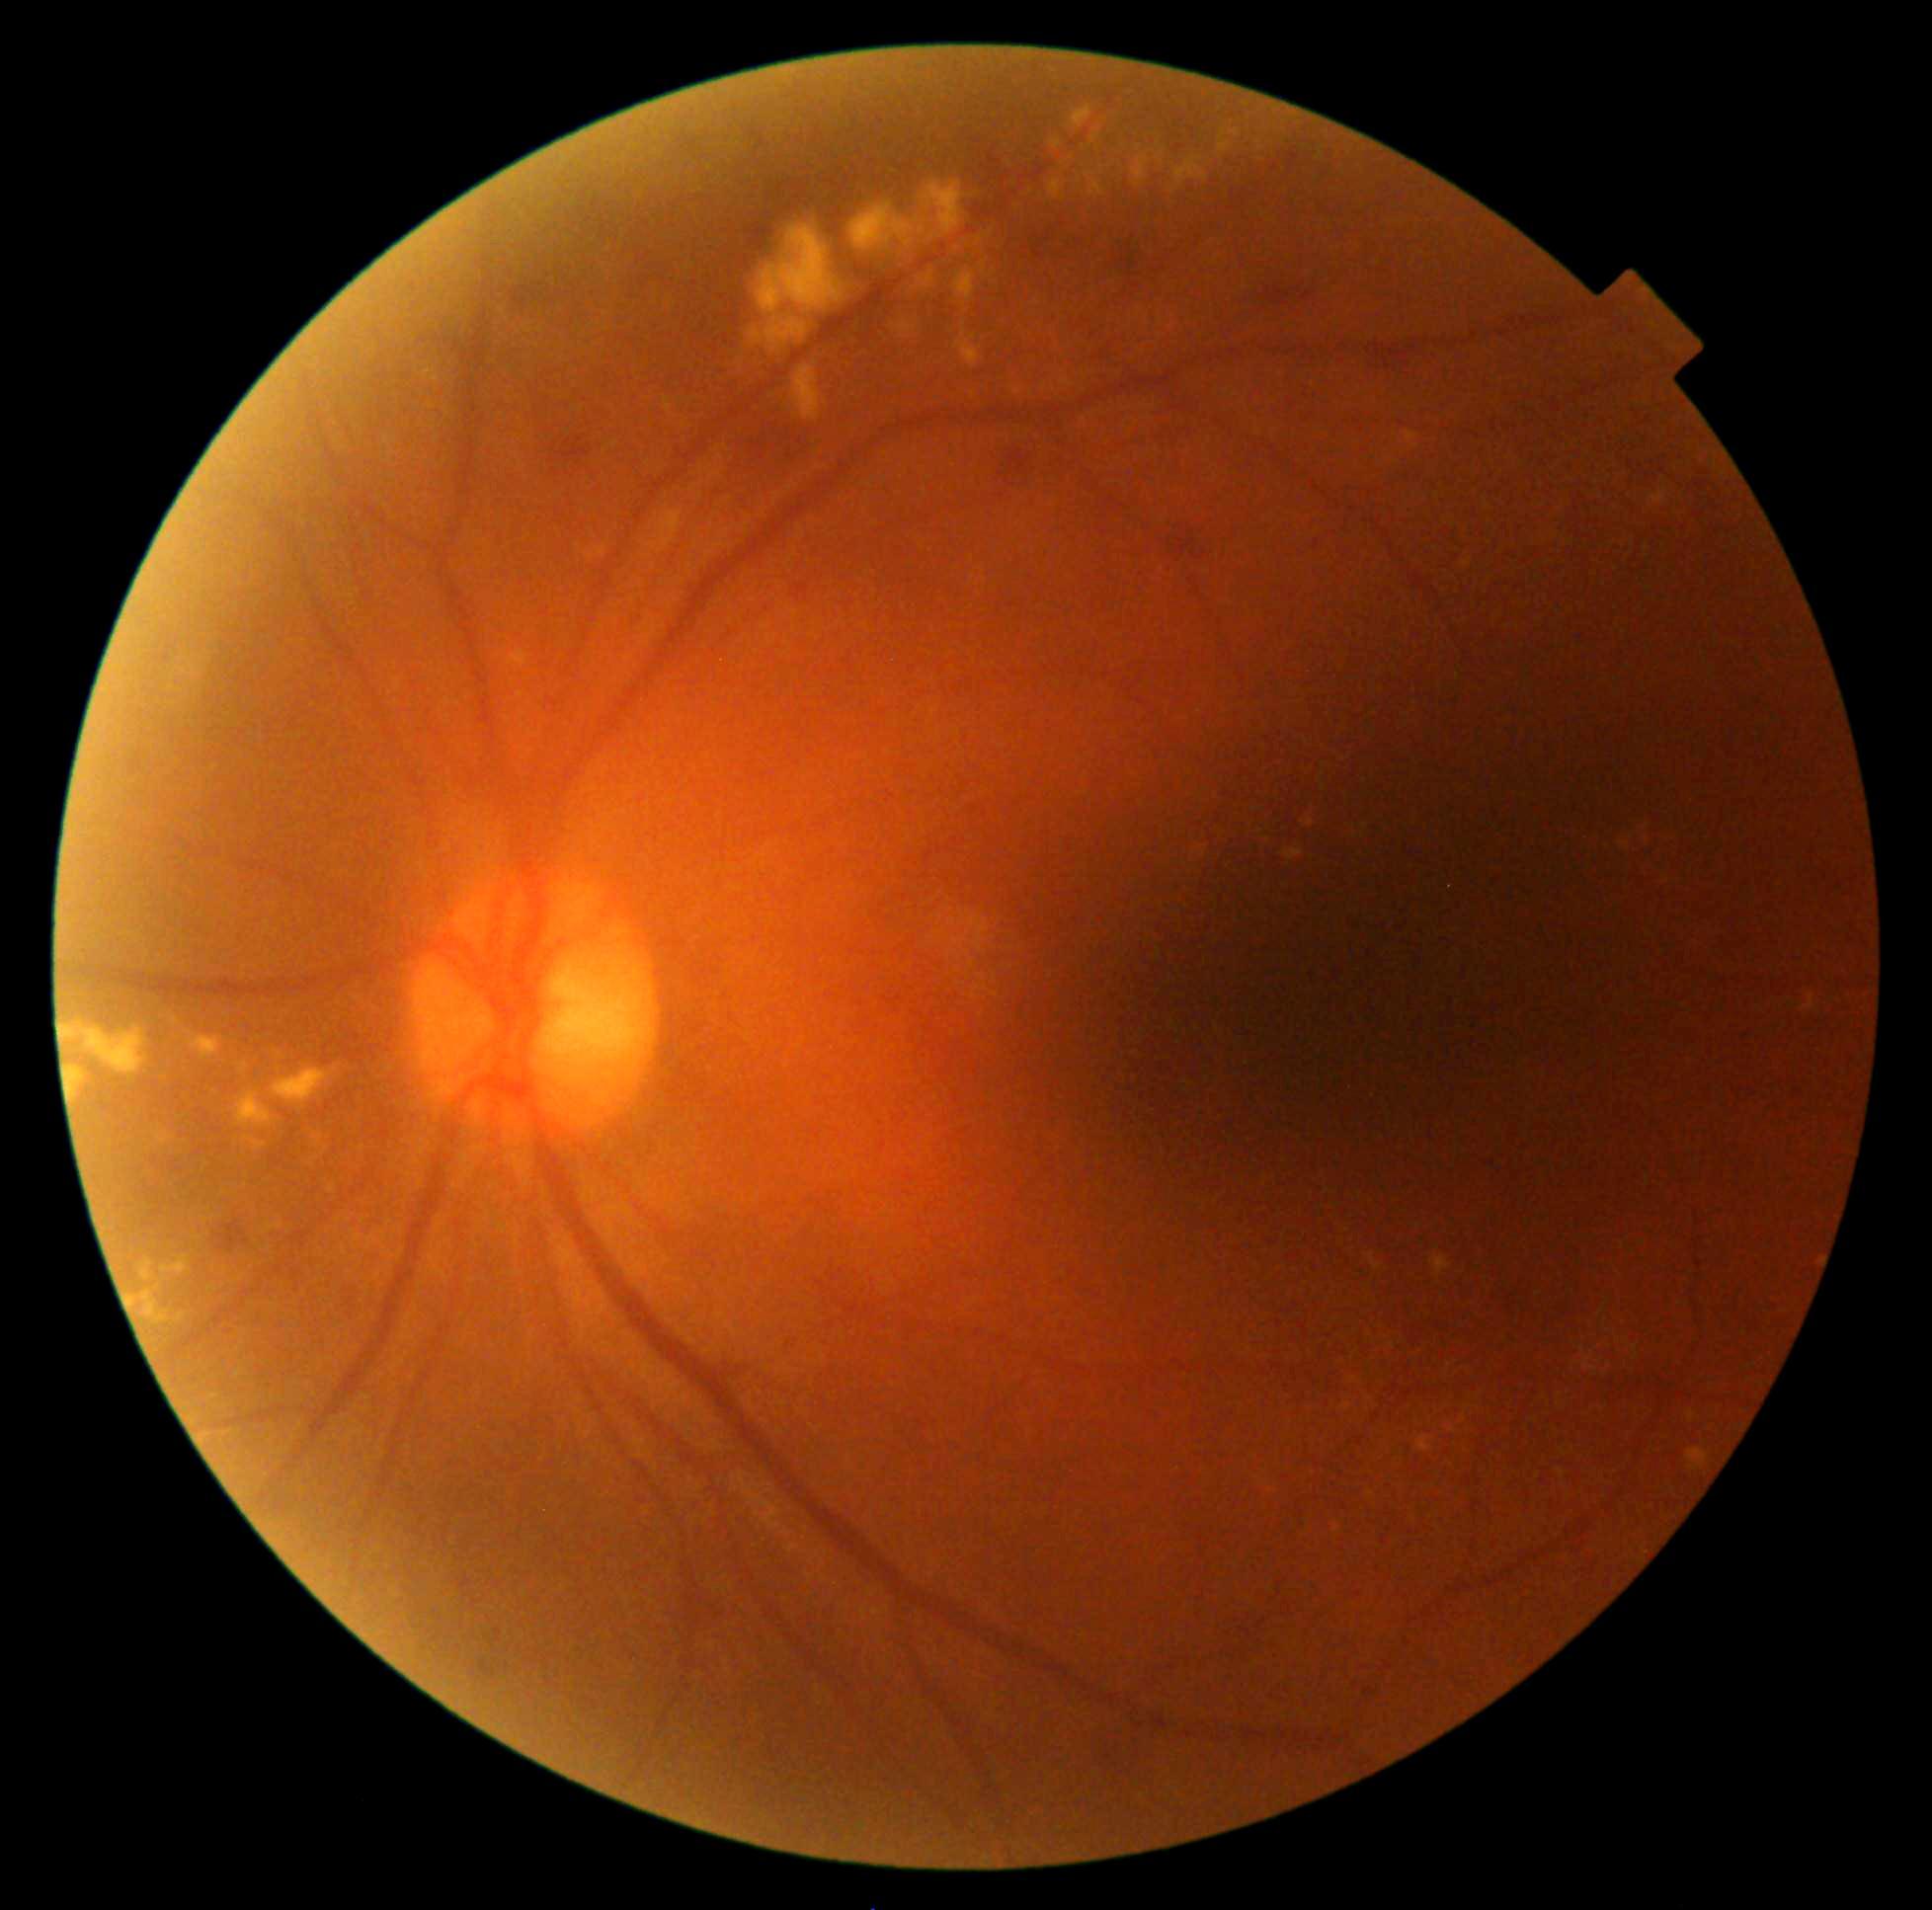 Diabetic retinopathy grade: 2 — more than just microaneurysms but less than severe NPDR
Selected lesions:
hard exudates (continued): <region>1802, 994, 1817, 1011</region>; <region>317, 1135, 324, 1145</region>; <region>247, 1138, 267, 1151</region>; <region>1417, 1436, 1431, 1452</region>; <region>850, 202, 929, 251</region>; <region>1651, 492, 1667, 504</region>; <region>1342, 1403, 1353, 1411</region>; <region>127, 1290, 170, 1325</region>; <region>360, 1145, 364, 1153</region>; <region>1073, 106, 1092, 129</region>; <region>1131, 156, 1149, 188</region>; <region>1176, 158, 1208, 187</region>; <region>1687, 1409, 1696, 1422</region>; <region>1621, 843, 1630, 850</region>
Small hard exudates near Point(974, 395); Point(210, 1289); Point(1045, 388); Point(1371, 1493)